1536 x 1152 pixels · FOV: 45 degrees — 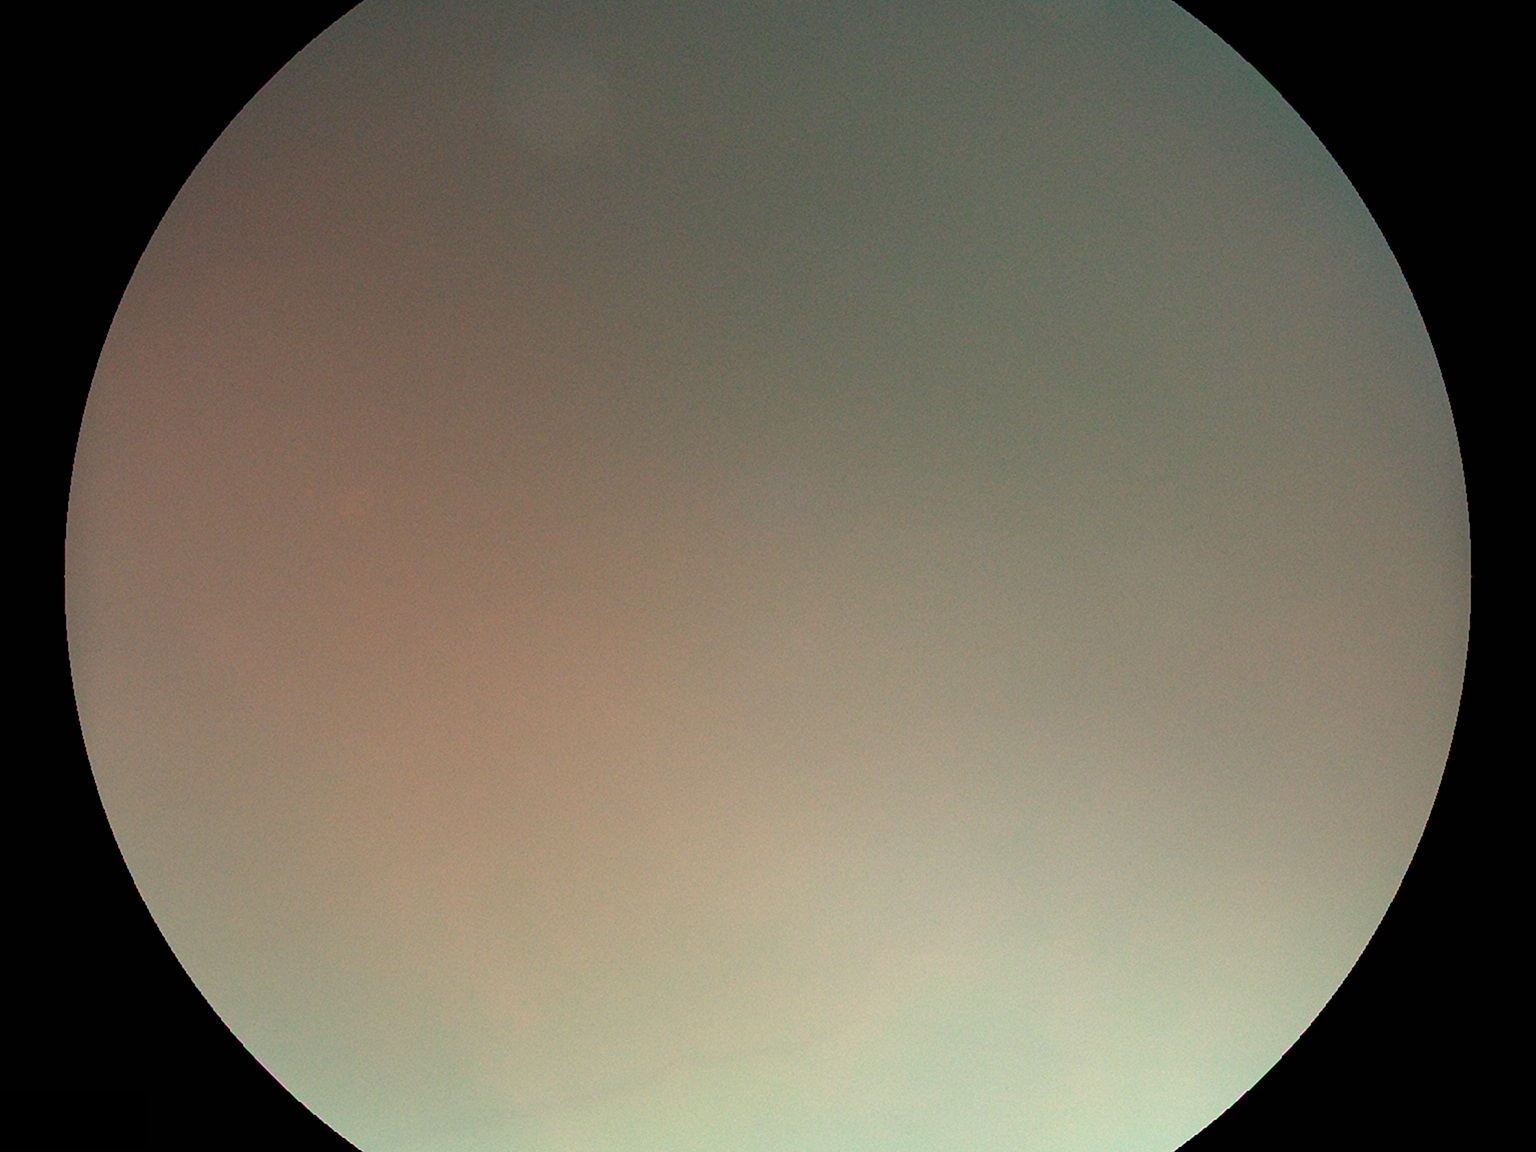

{"quality": "insufficient for DR assessment", "dr_grade": "ungradable"}